Wide-field fundus photograph from neonatal ROP screening
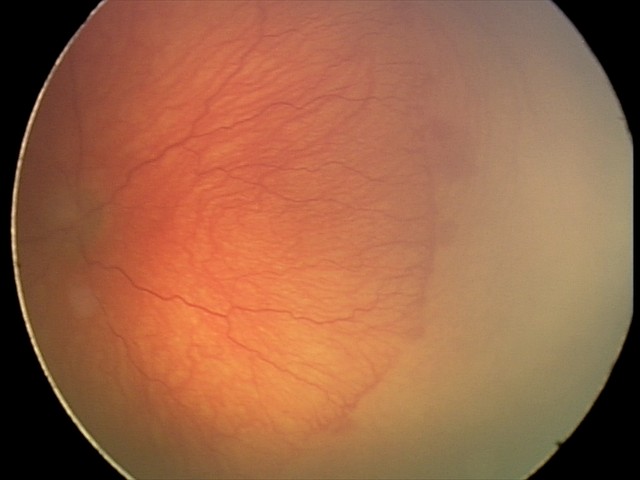 Plus disease present.
Series diagnosed as aggressive retinopathy of prematurity.